Pediatric wide-field fundus photograph
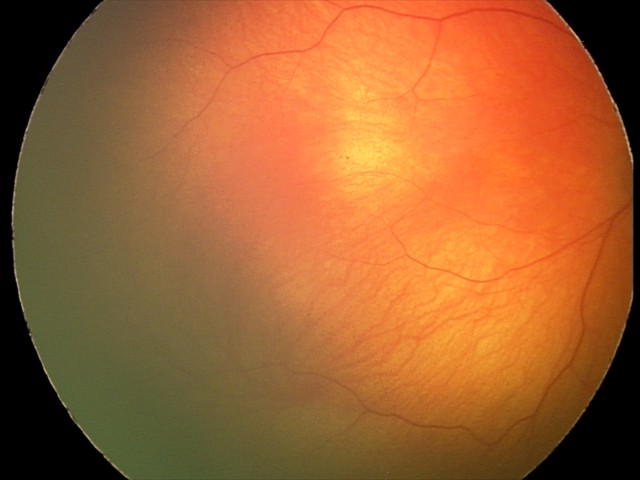 Screening examination diagnosed as physiological.